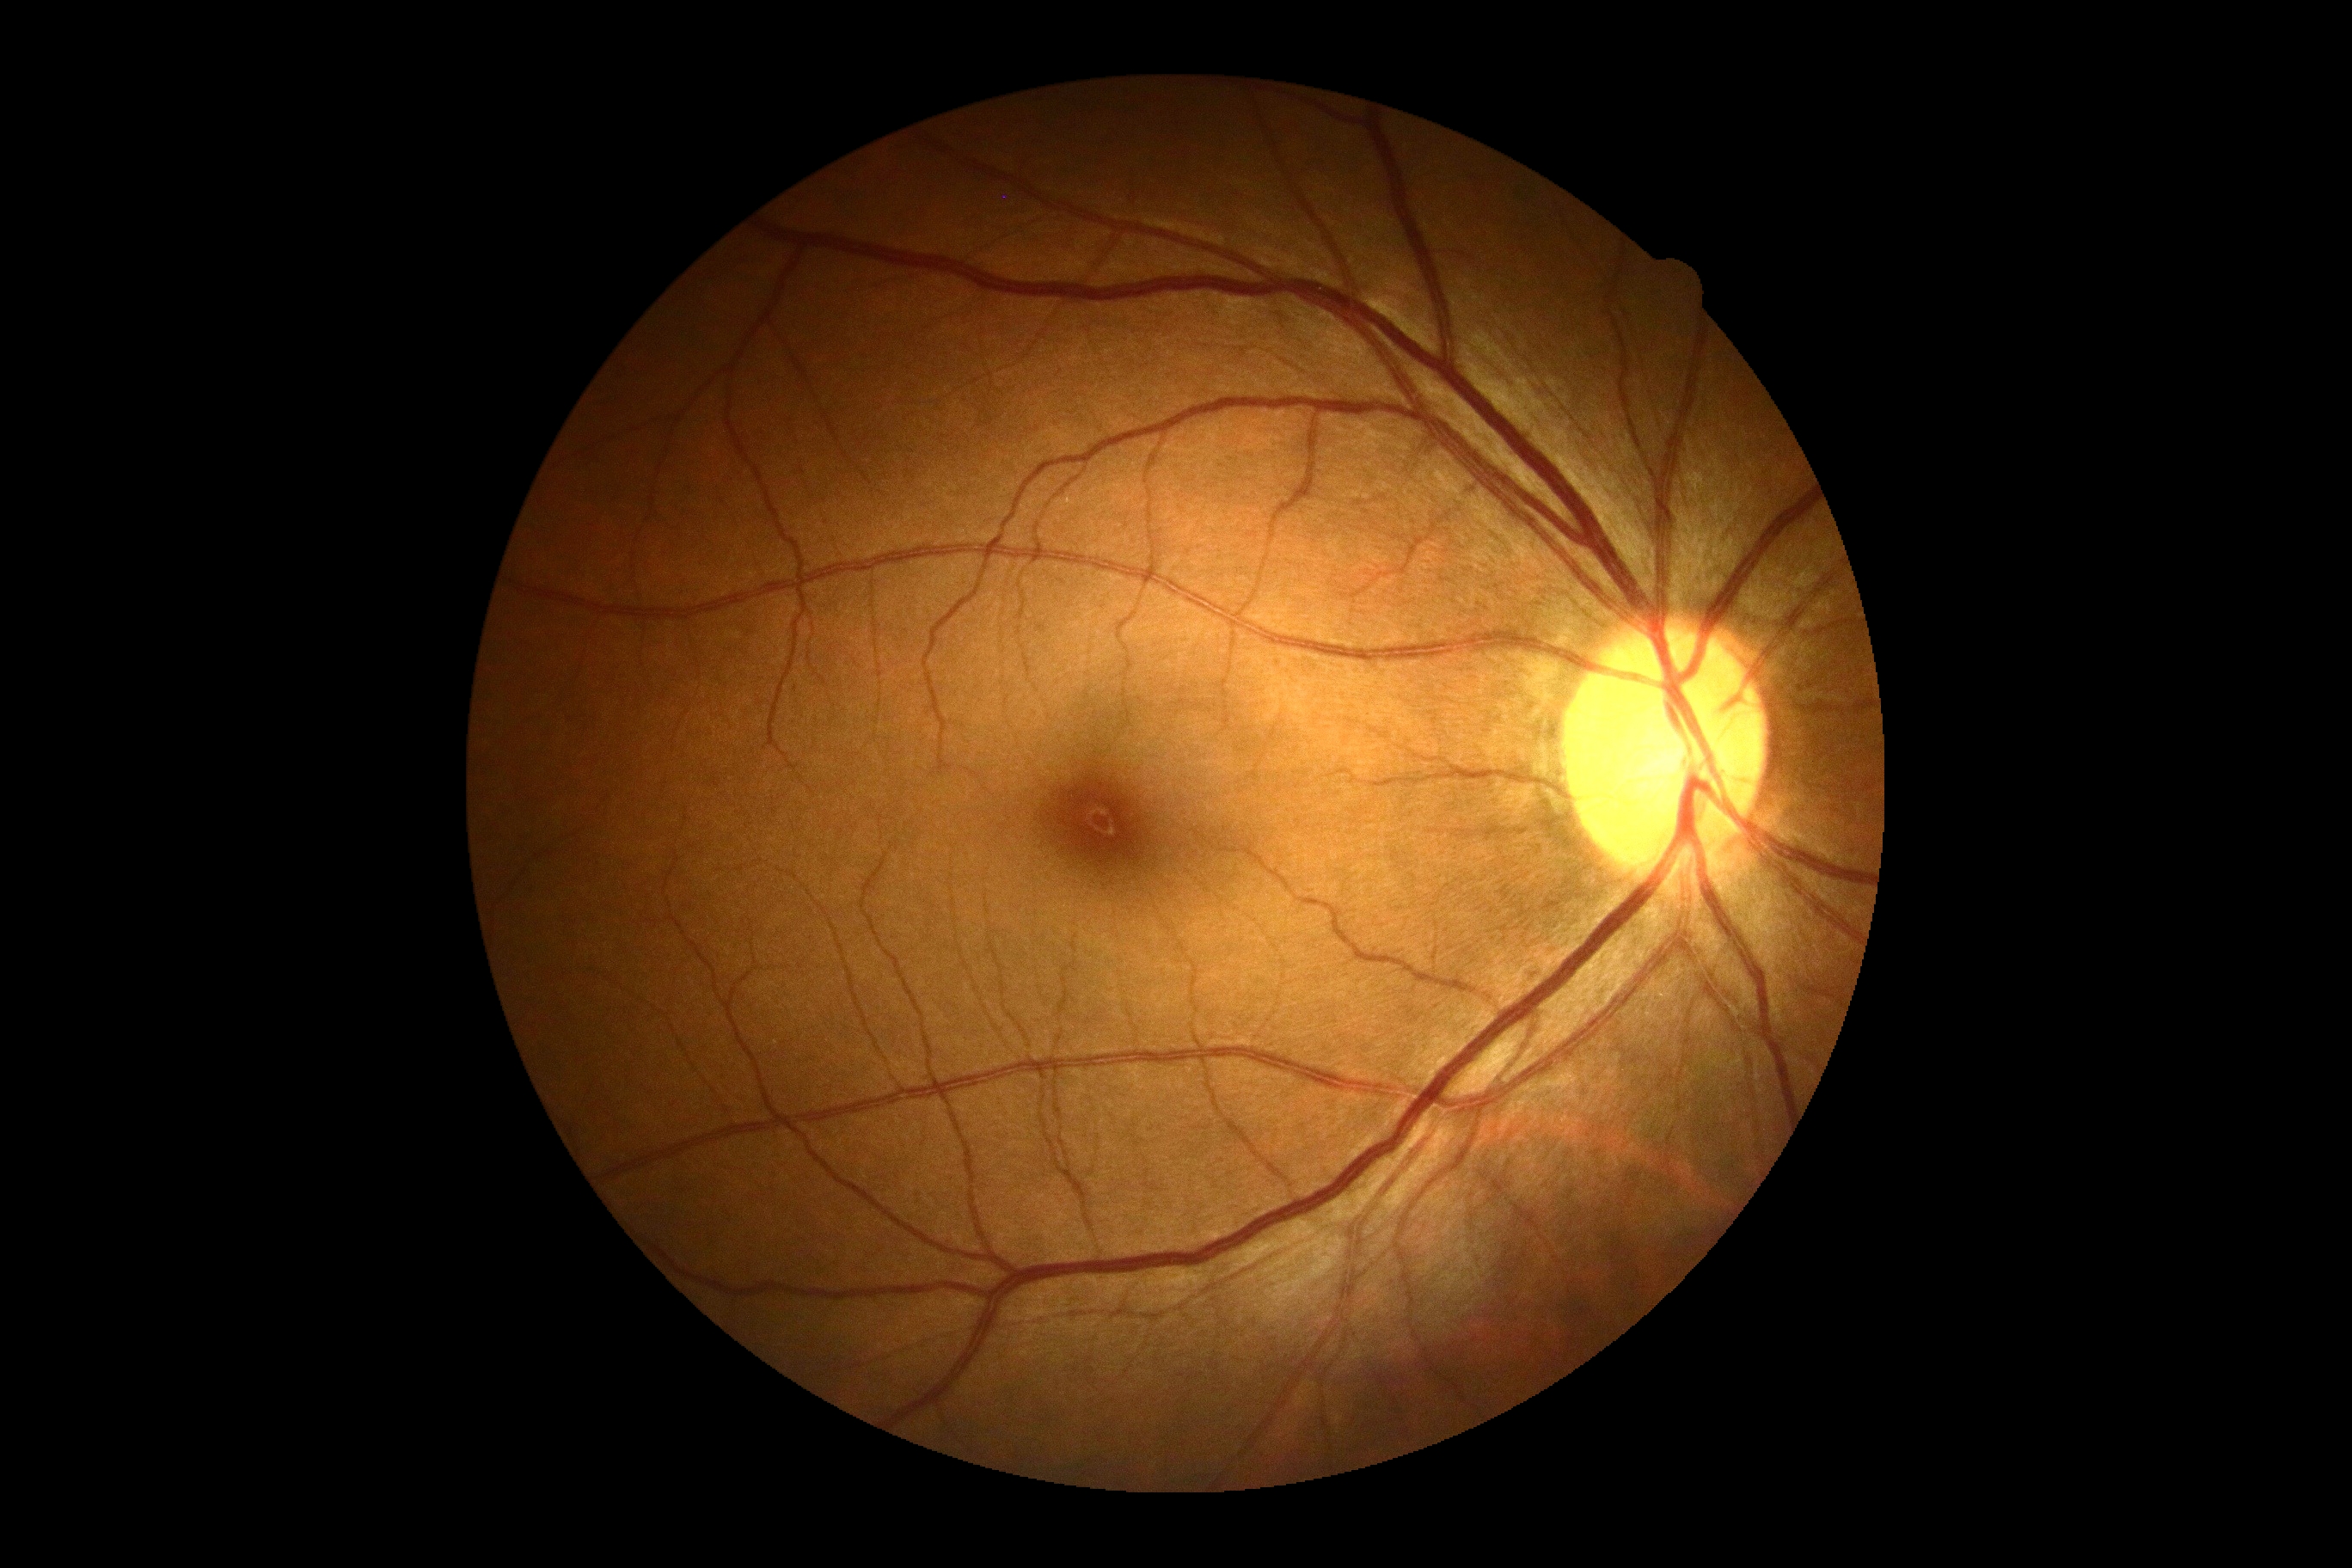
diabetic retinopathy (DR) = no apparent diabetic retinopathy (grade 0).